RetCam wide-field infant fundus image. 1440x1080px. 130° field of view (Natus RetCam Envision).
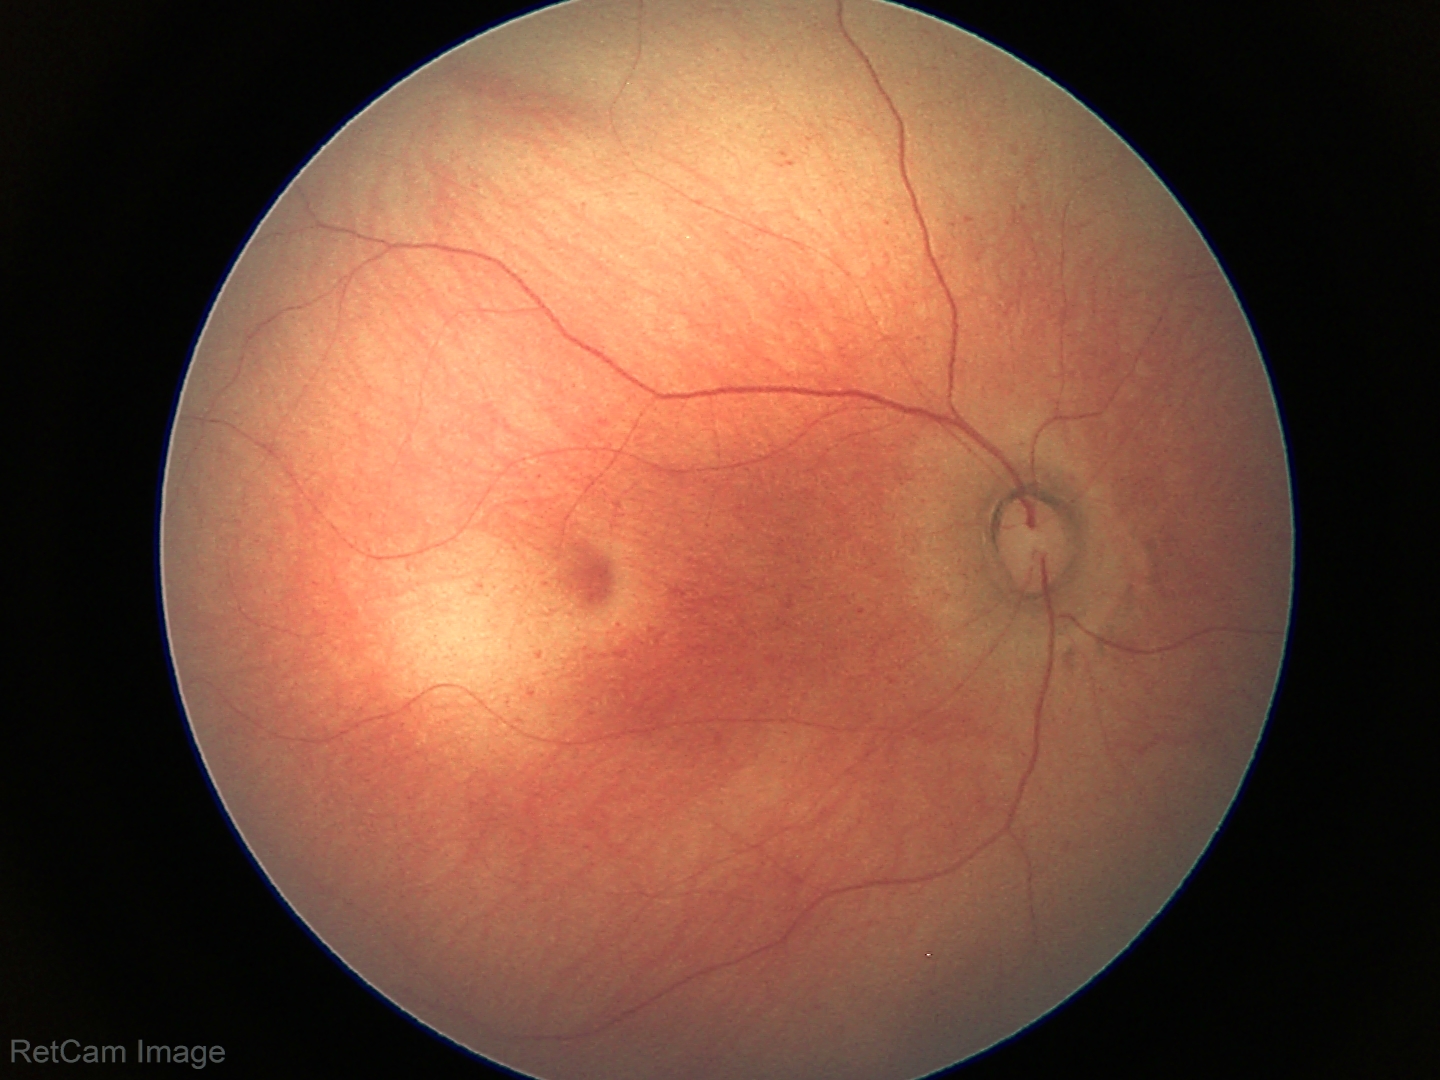 Q: What was the screening finding?
A: normal retinal appearance